FOV: 45 degrees. Posterior pole photograph
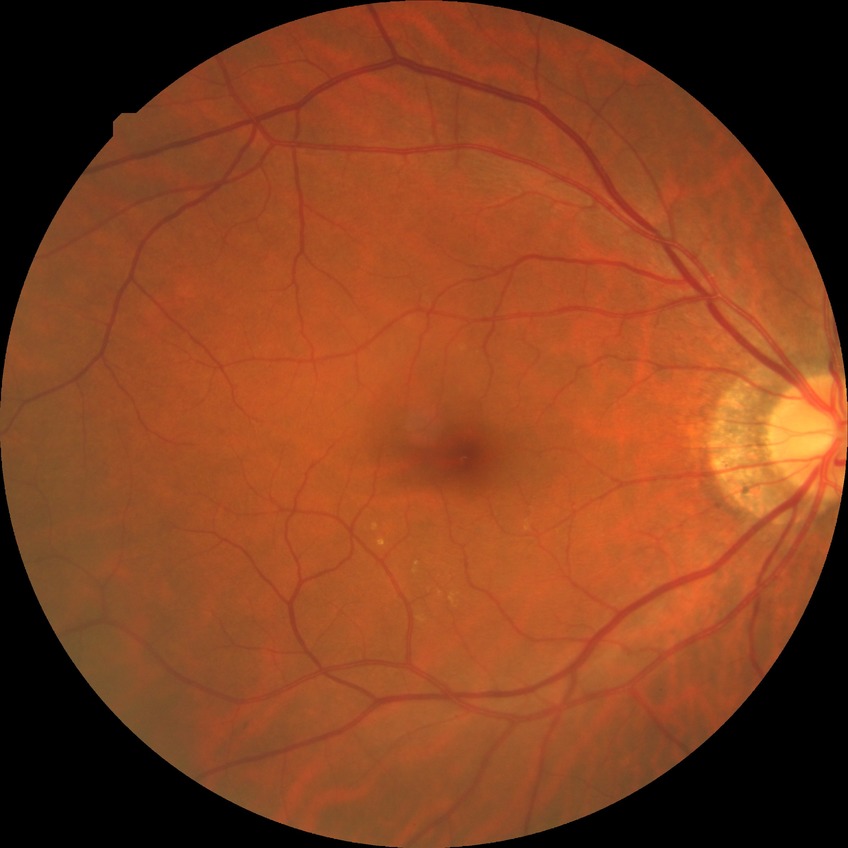
modified Davis grading: no diabetic retinopathy.